45° FOV. Image size 848x848.
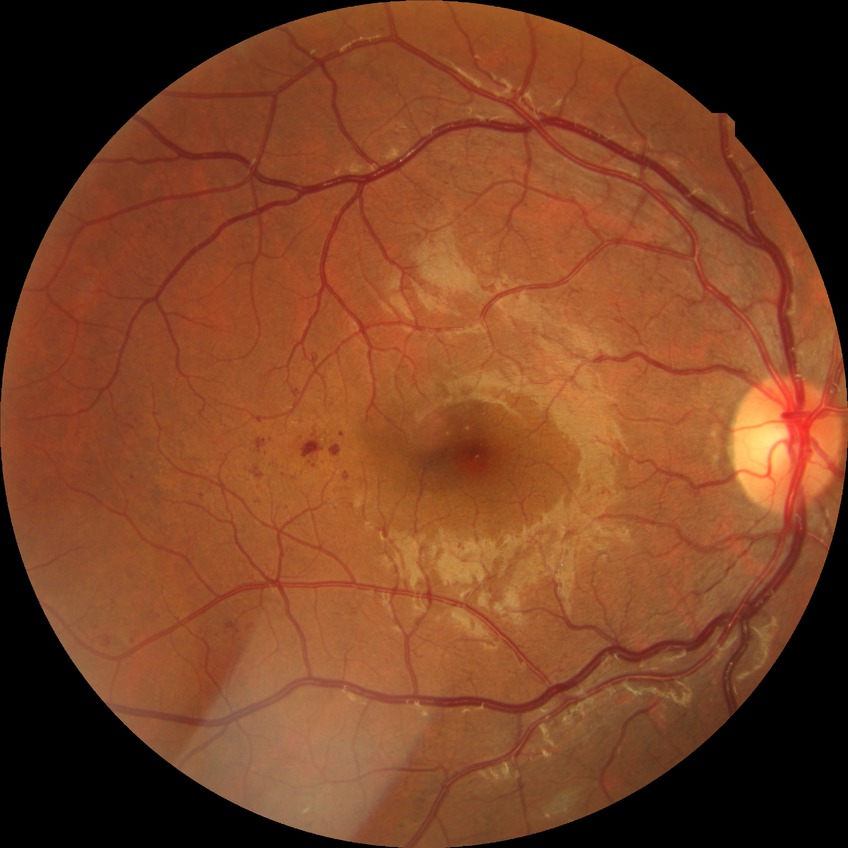
{"davis_grade": "PPDR"}